Wide-field fundus photograph from neonatal ROP screening: 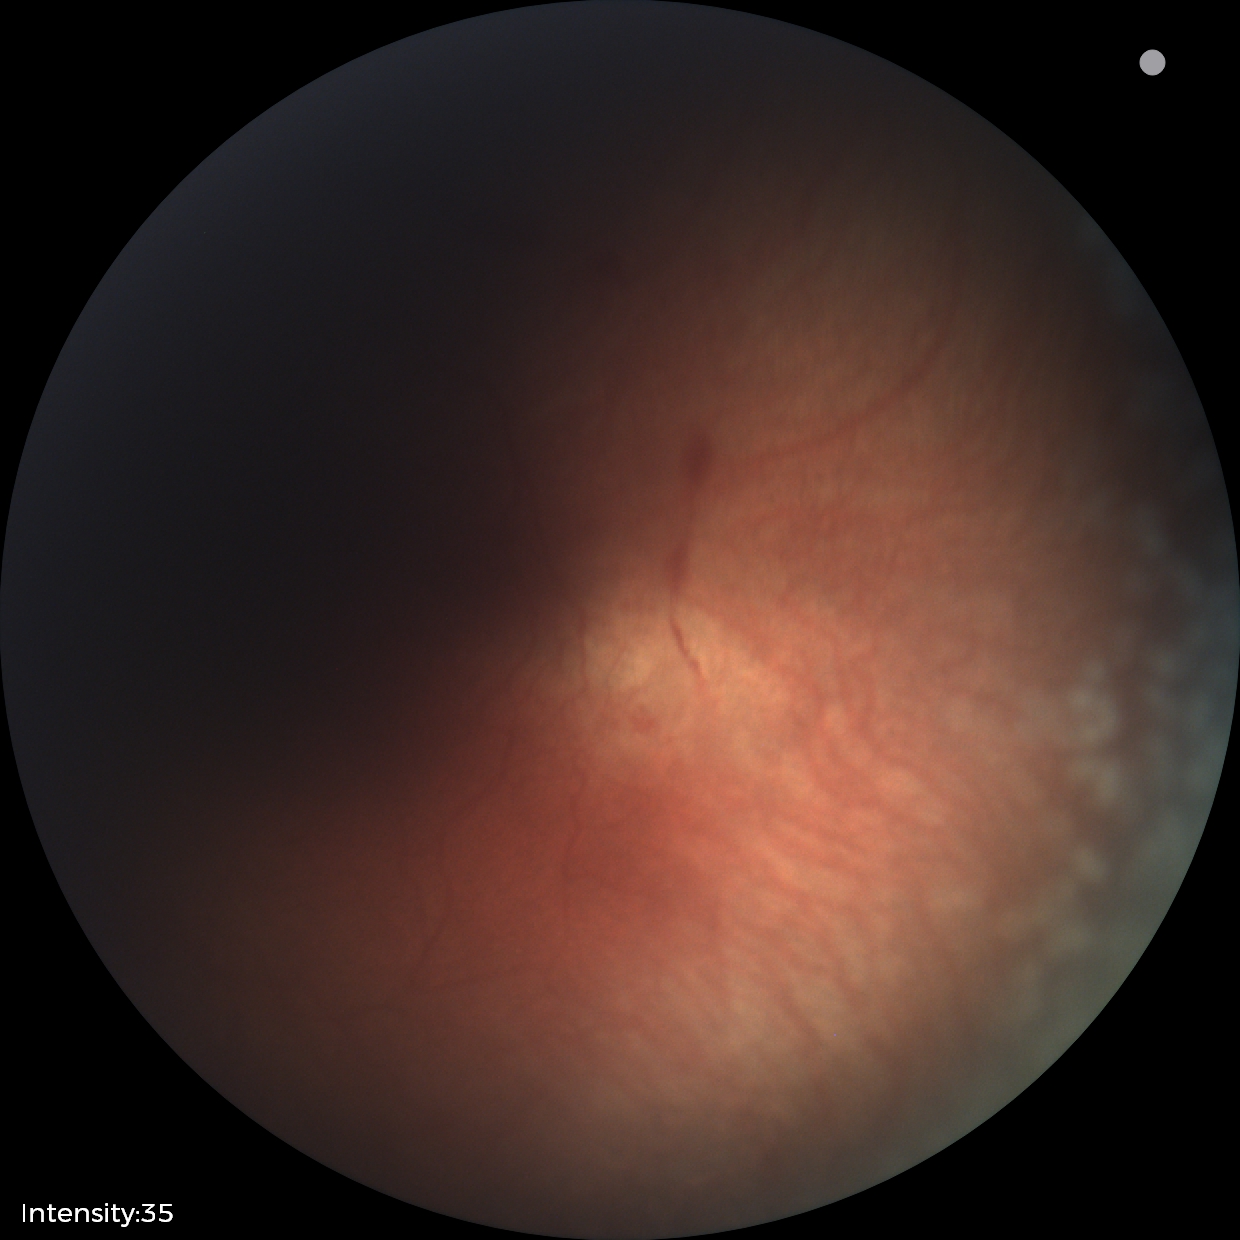
Q: What is the plus-form classification?
A: plus disease
Q: What was the screening finding?
A: ROP stage 2